Acquired on the Clarity RetCam 3; wide-field fundus image from infant ROP screening:
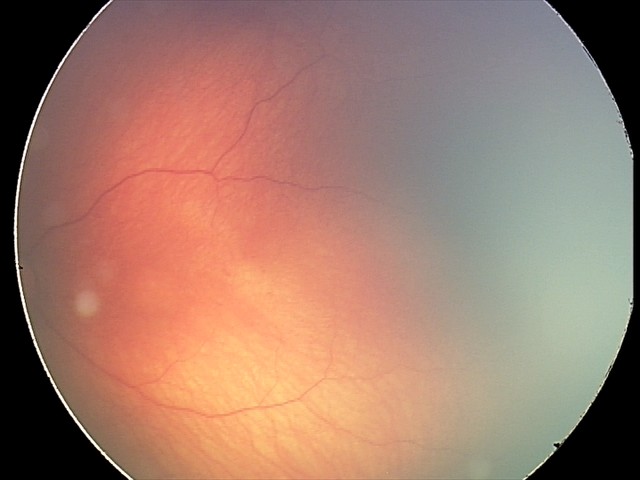

Screening series with retinal hemorrhages.